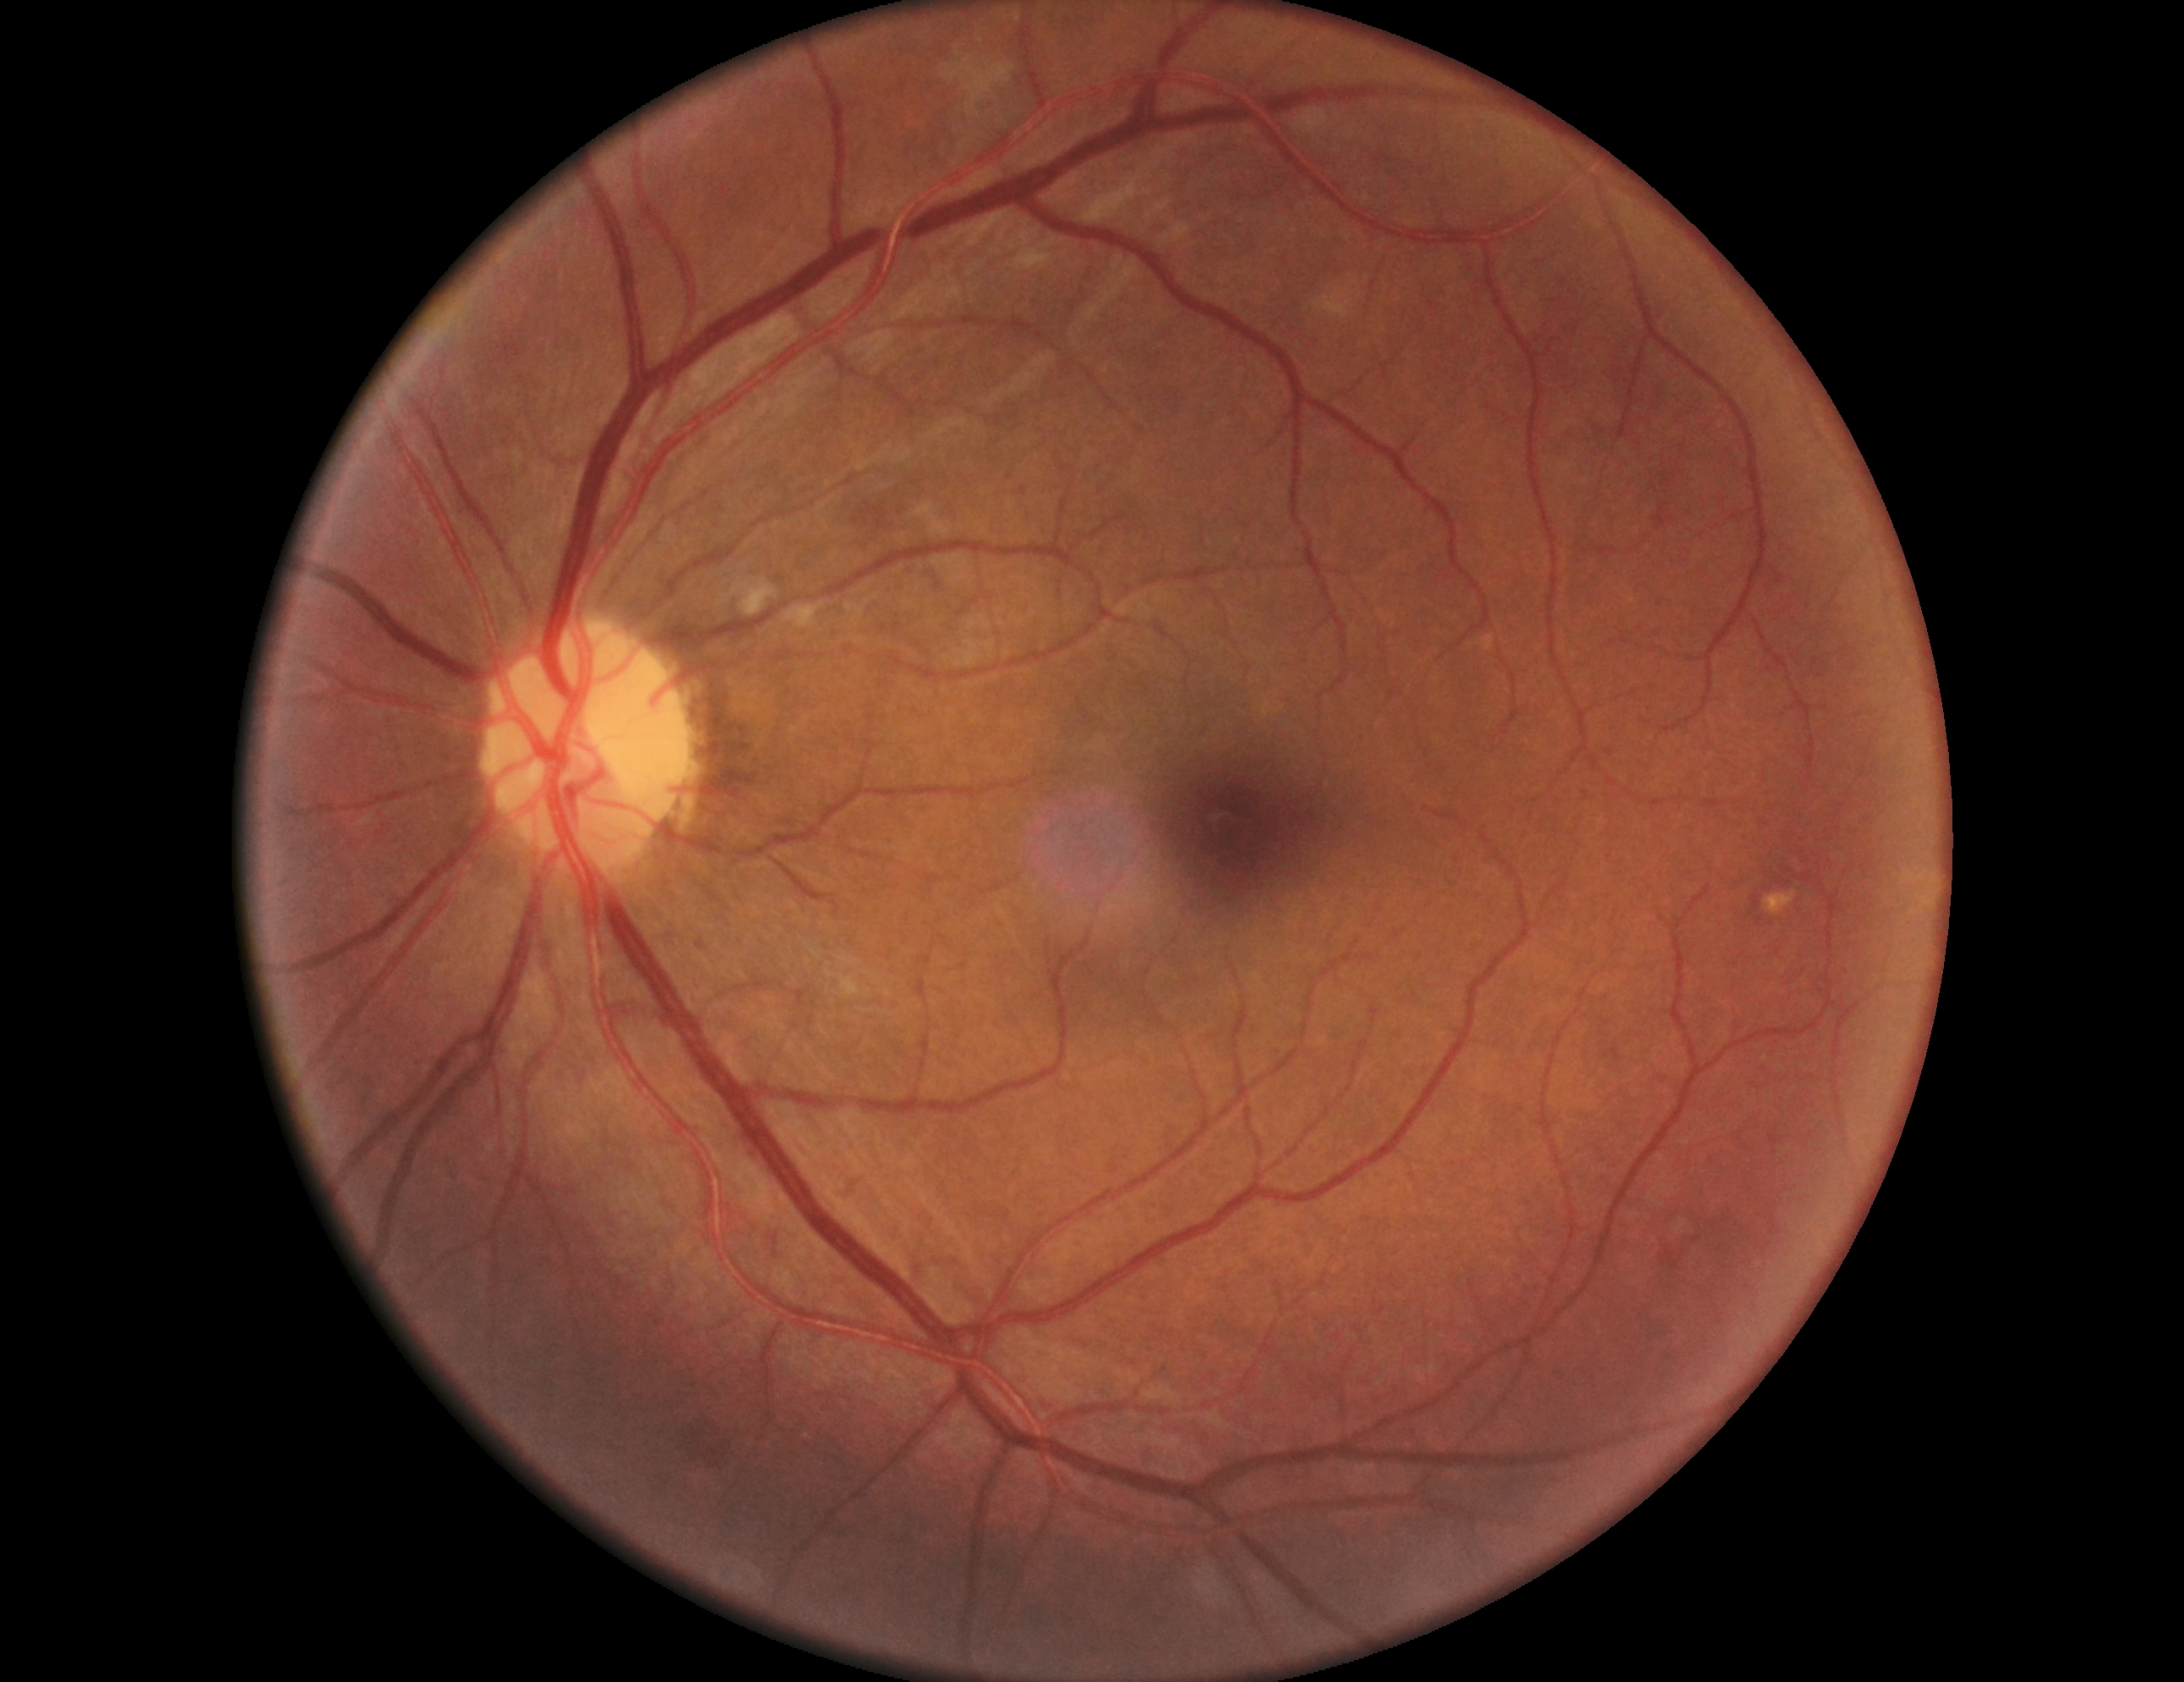
Diabetic retinopathy grade is 2 (moderate NPDR).